Retinal fundus photograph — 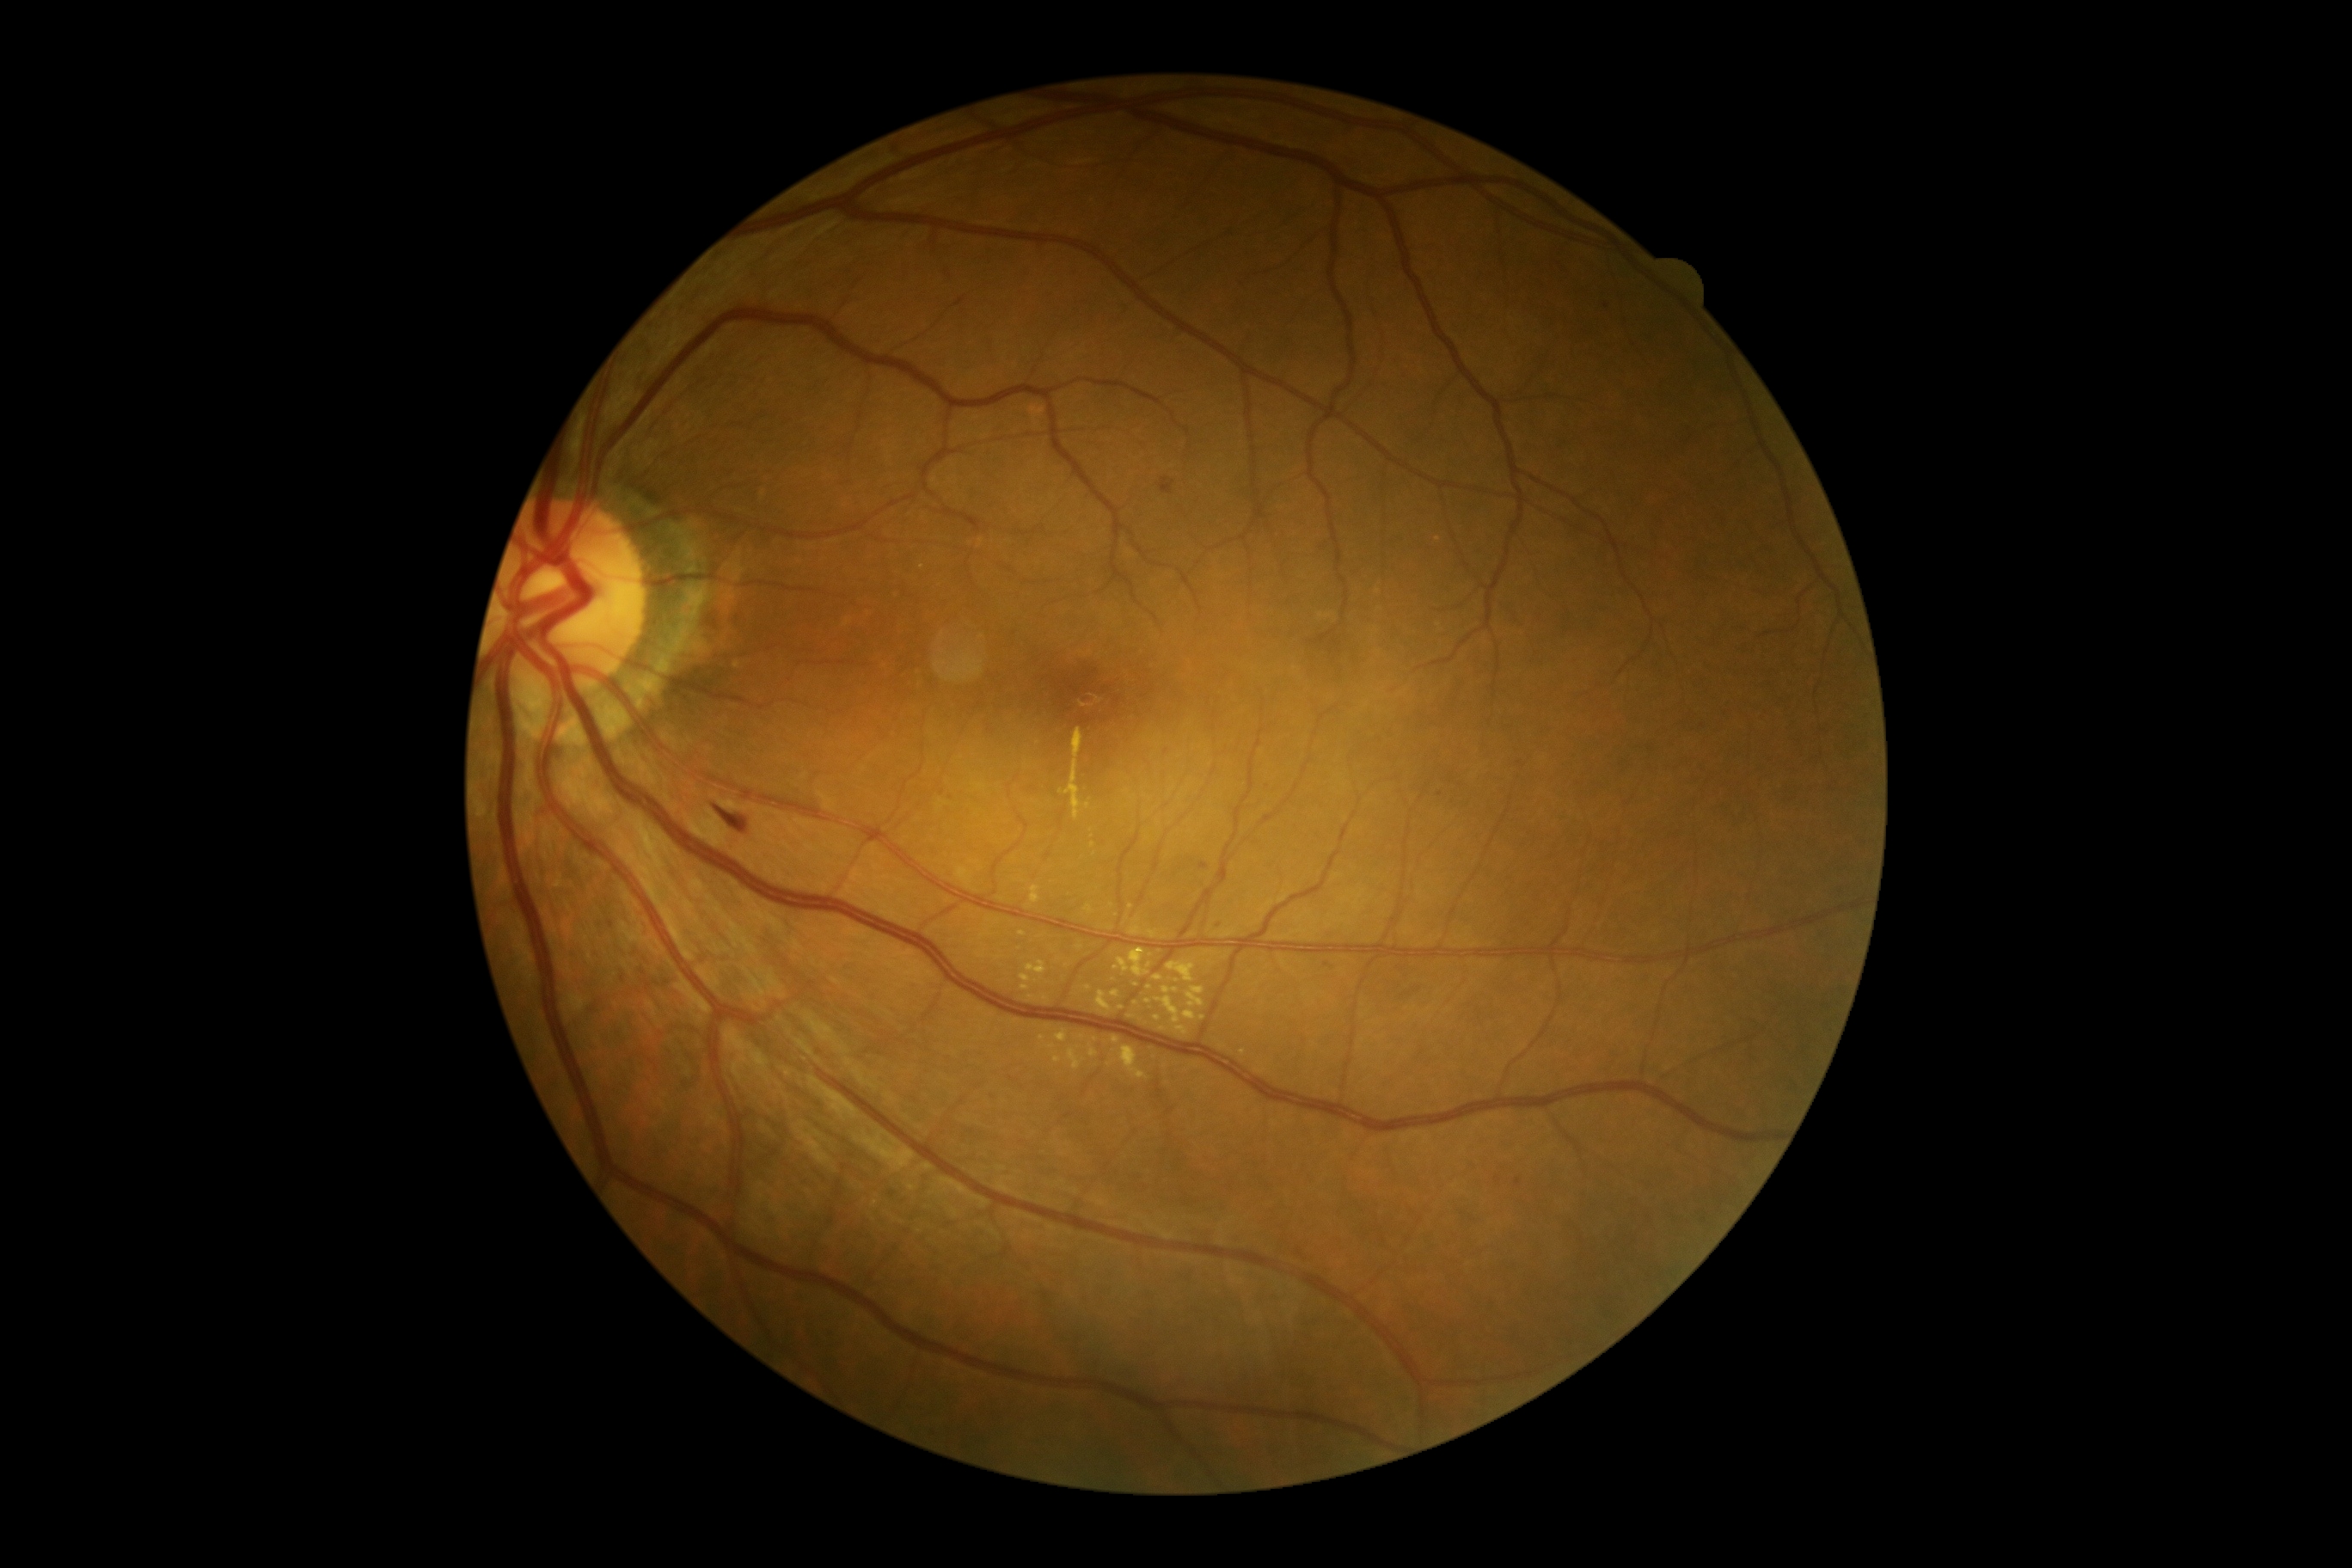

{"partial": true, "dr_grade": 2, "dr_grade_name": "moderate NPDR", "lesions": {"ex": [[1020, 974, 1032, 991], [1120, 1046, 1148, 1081], [1149, 931, 1158, 940], [1185, 988, 1203, 1008], [1184, 1012, 1197, 1020], [1055, 1031, 1069, 1043], [1156, 998, 1180, 1024]], "ex_small_centers": [[1110, 1065], [1177, 981], [1046, 998], [1080, 949], [1150, 988], [1195, 1066], [1122, 1007]]}}